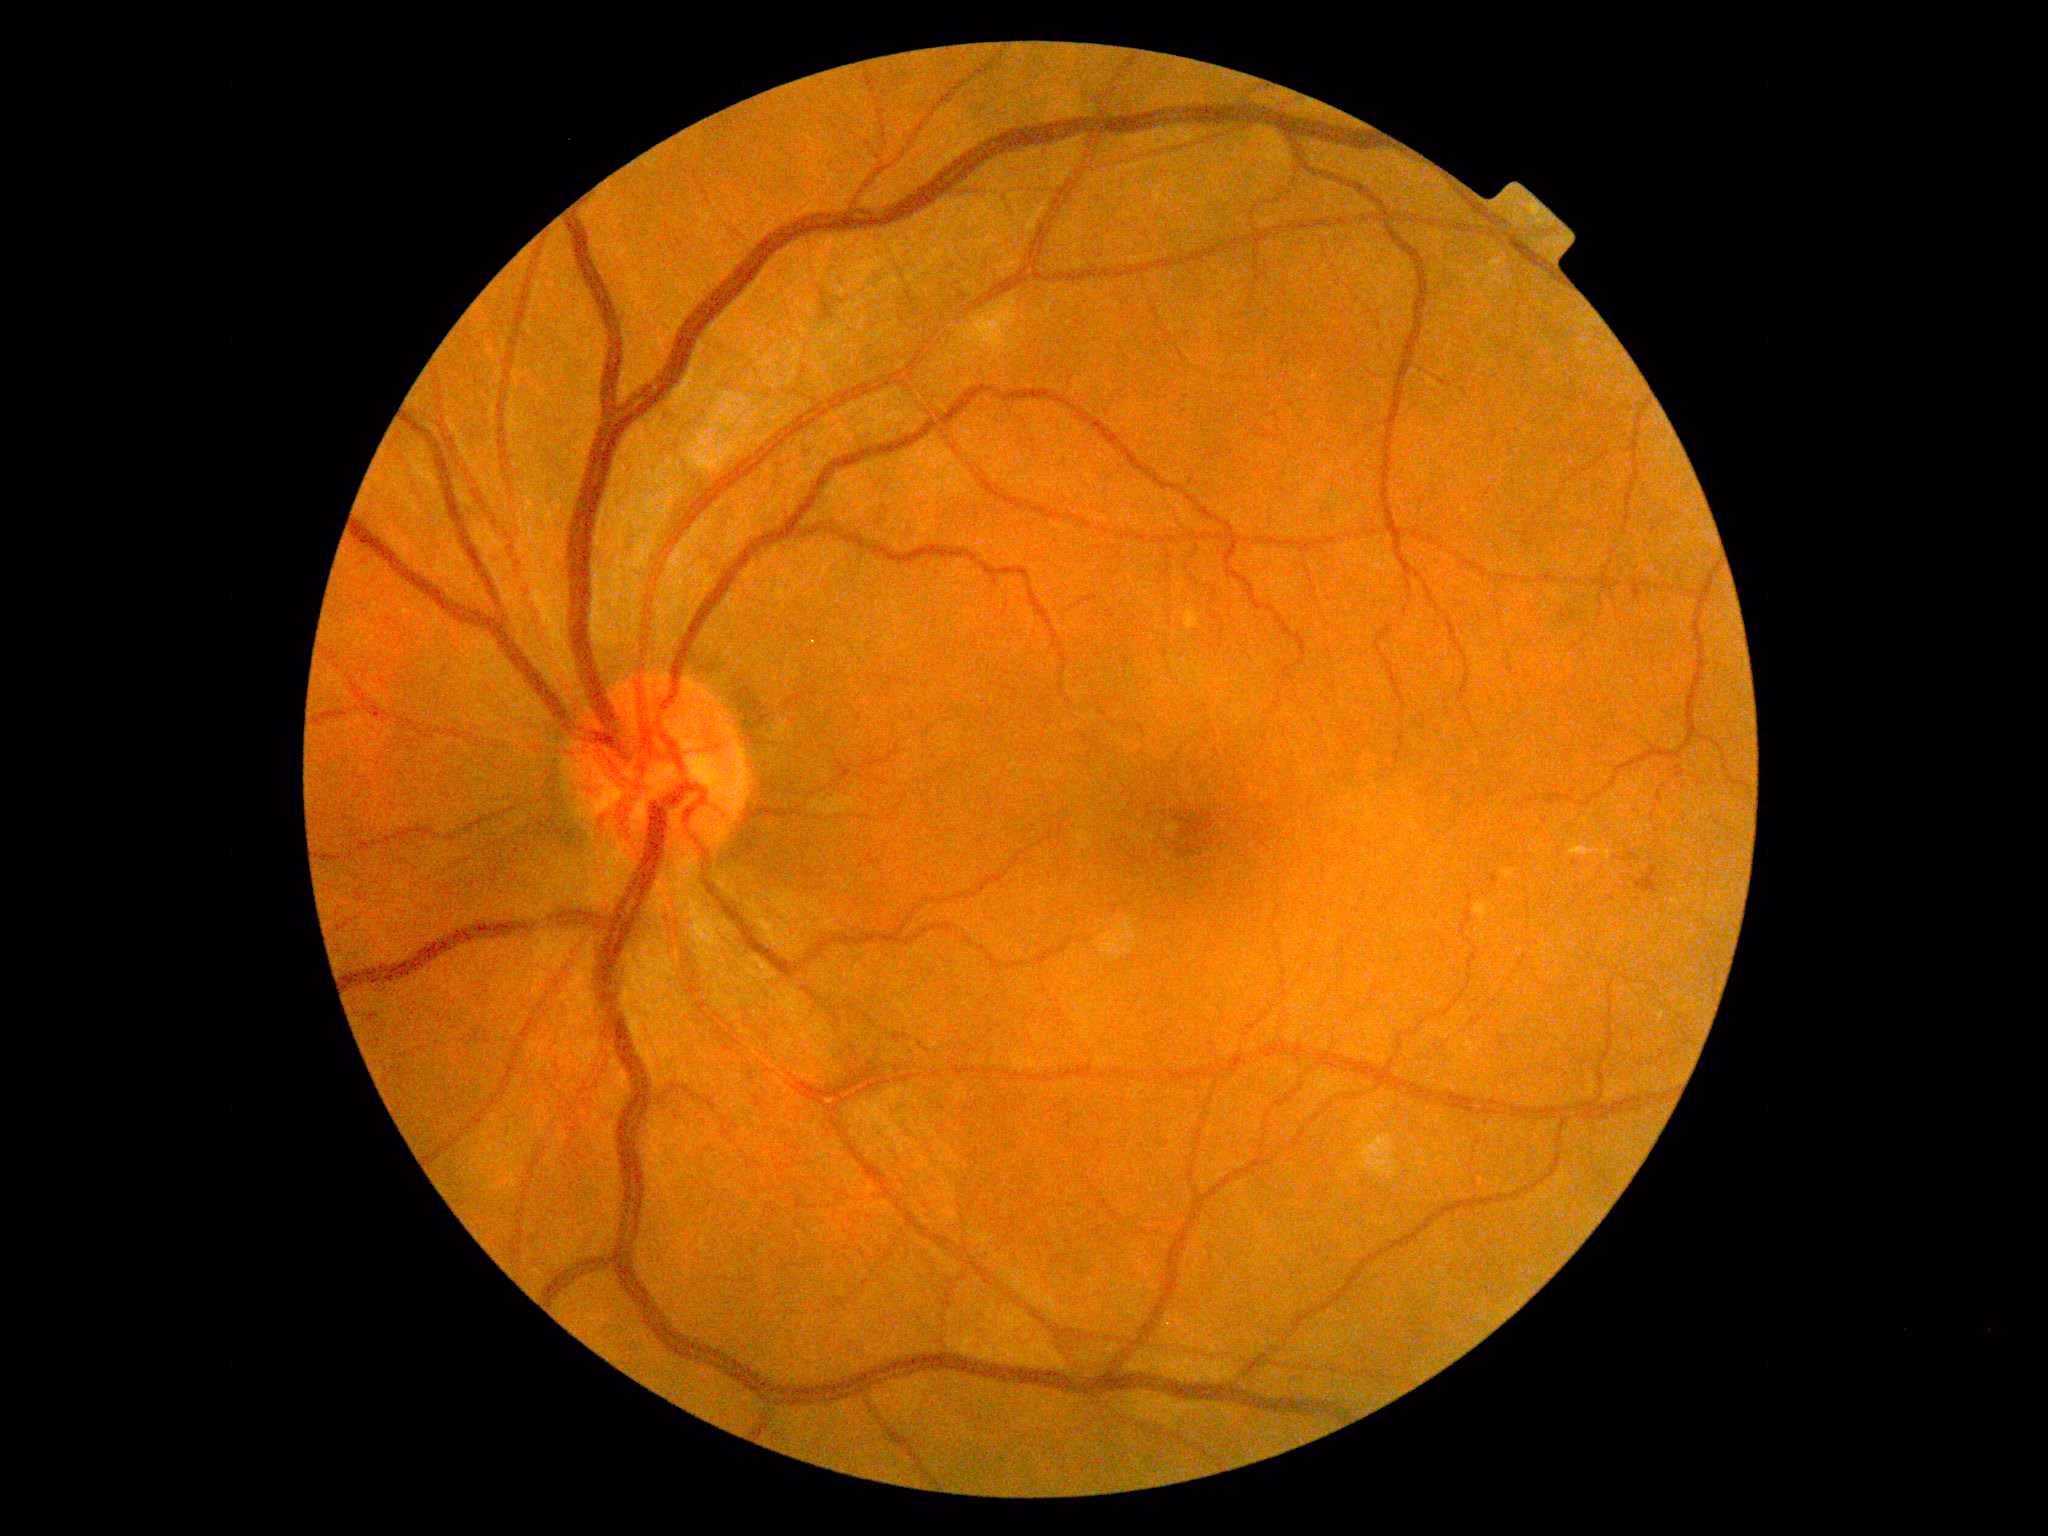

Diabetic retinopathy: grade 2 (moderate NPDR).